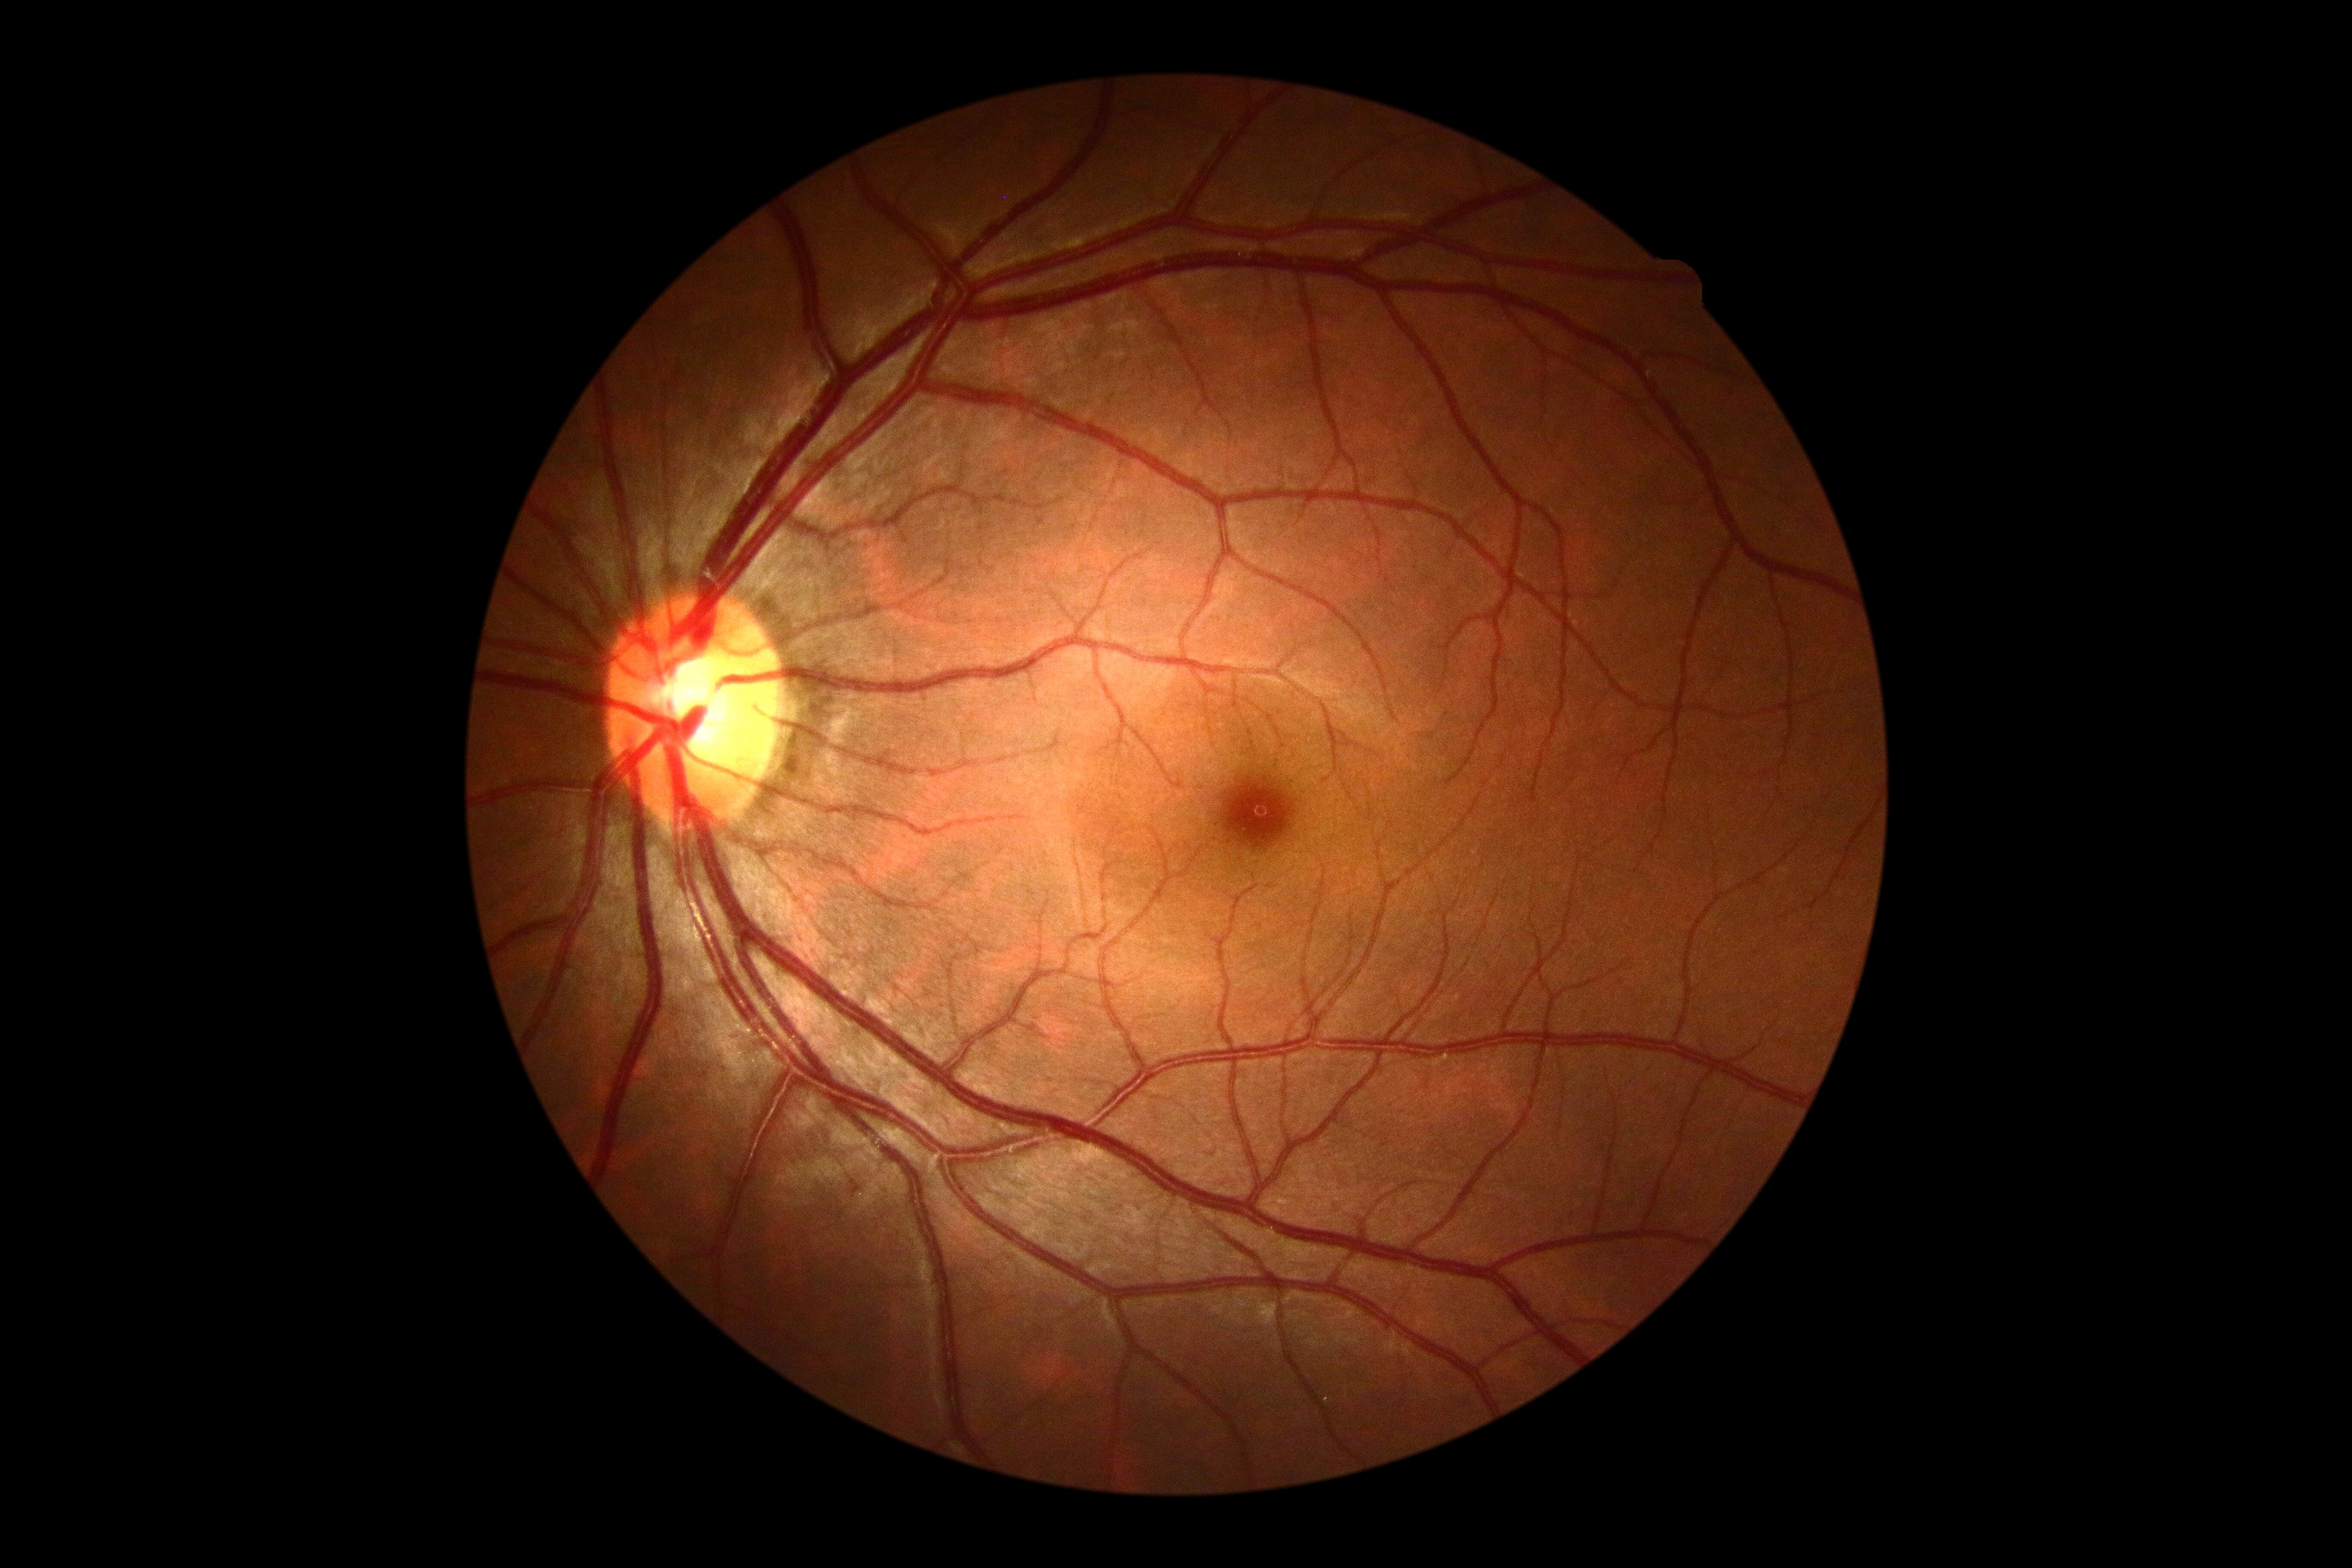

Diabetic retinopathy (DR): 0.